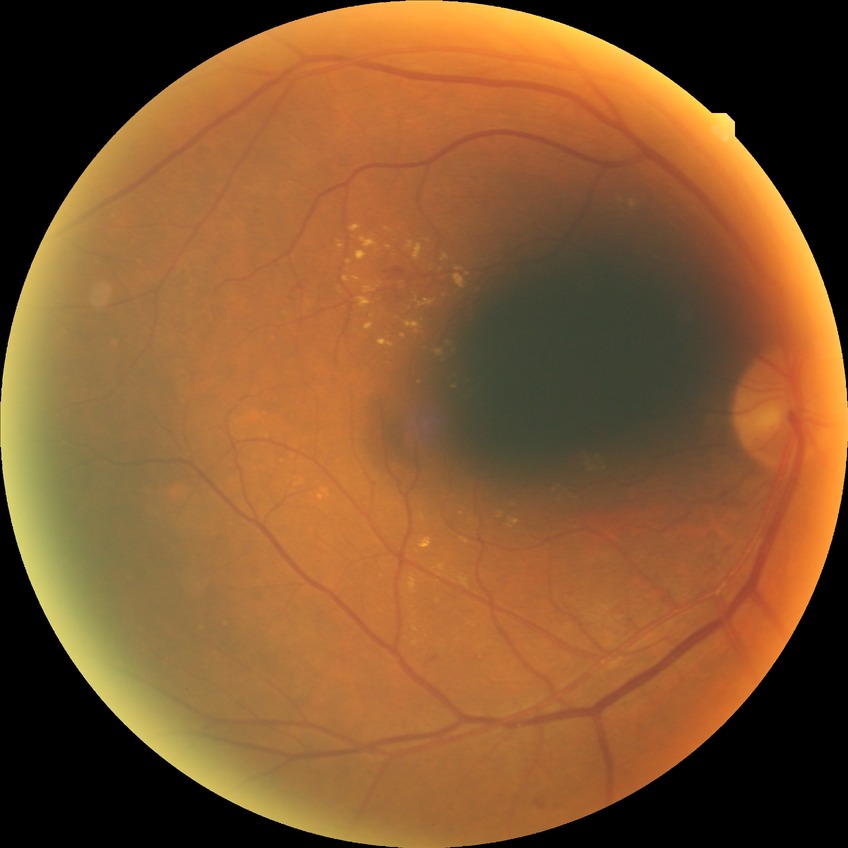
Diabetic retinopathy stage: simple diabetic retinopathy.